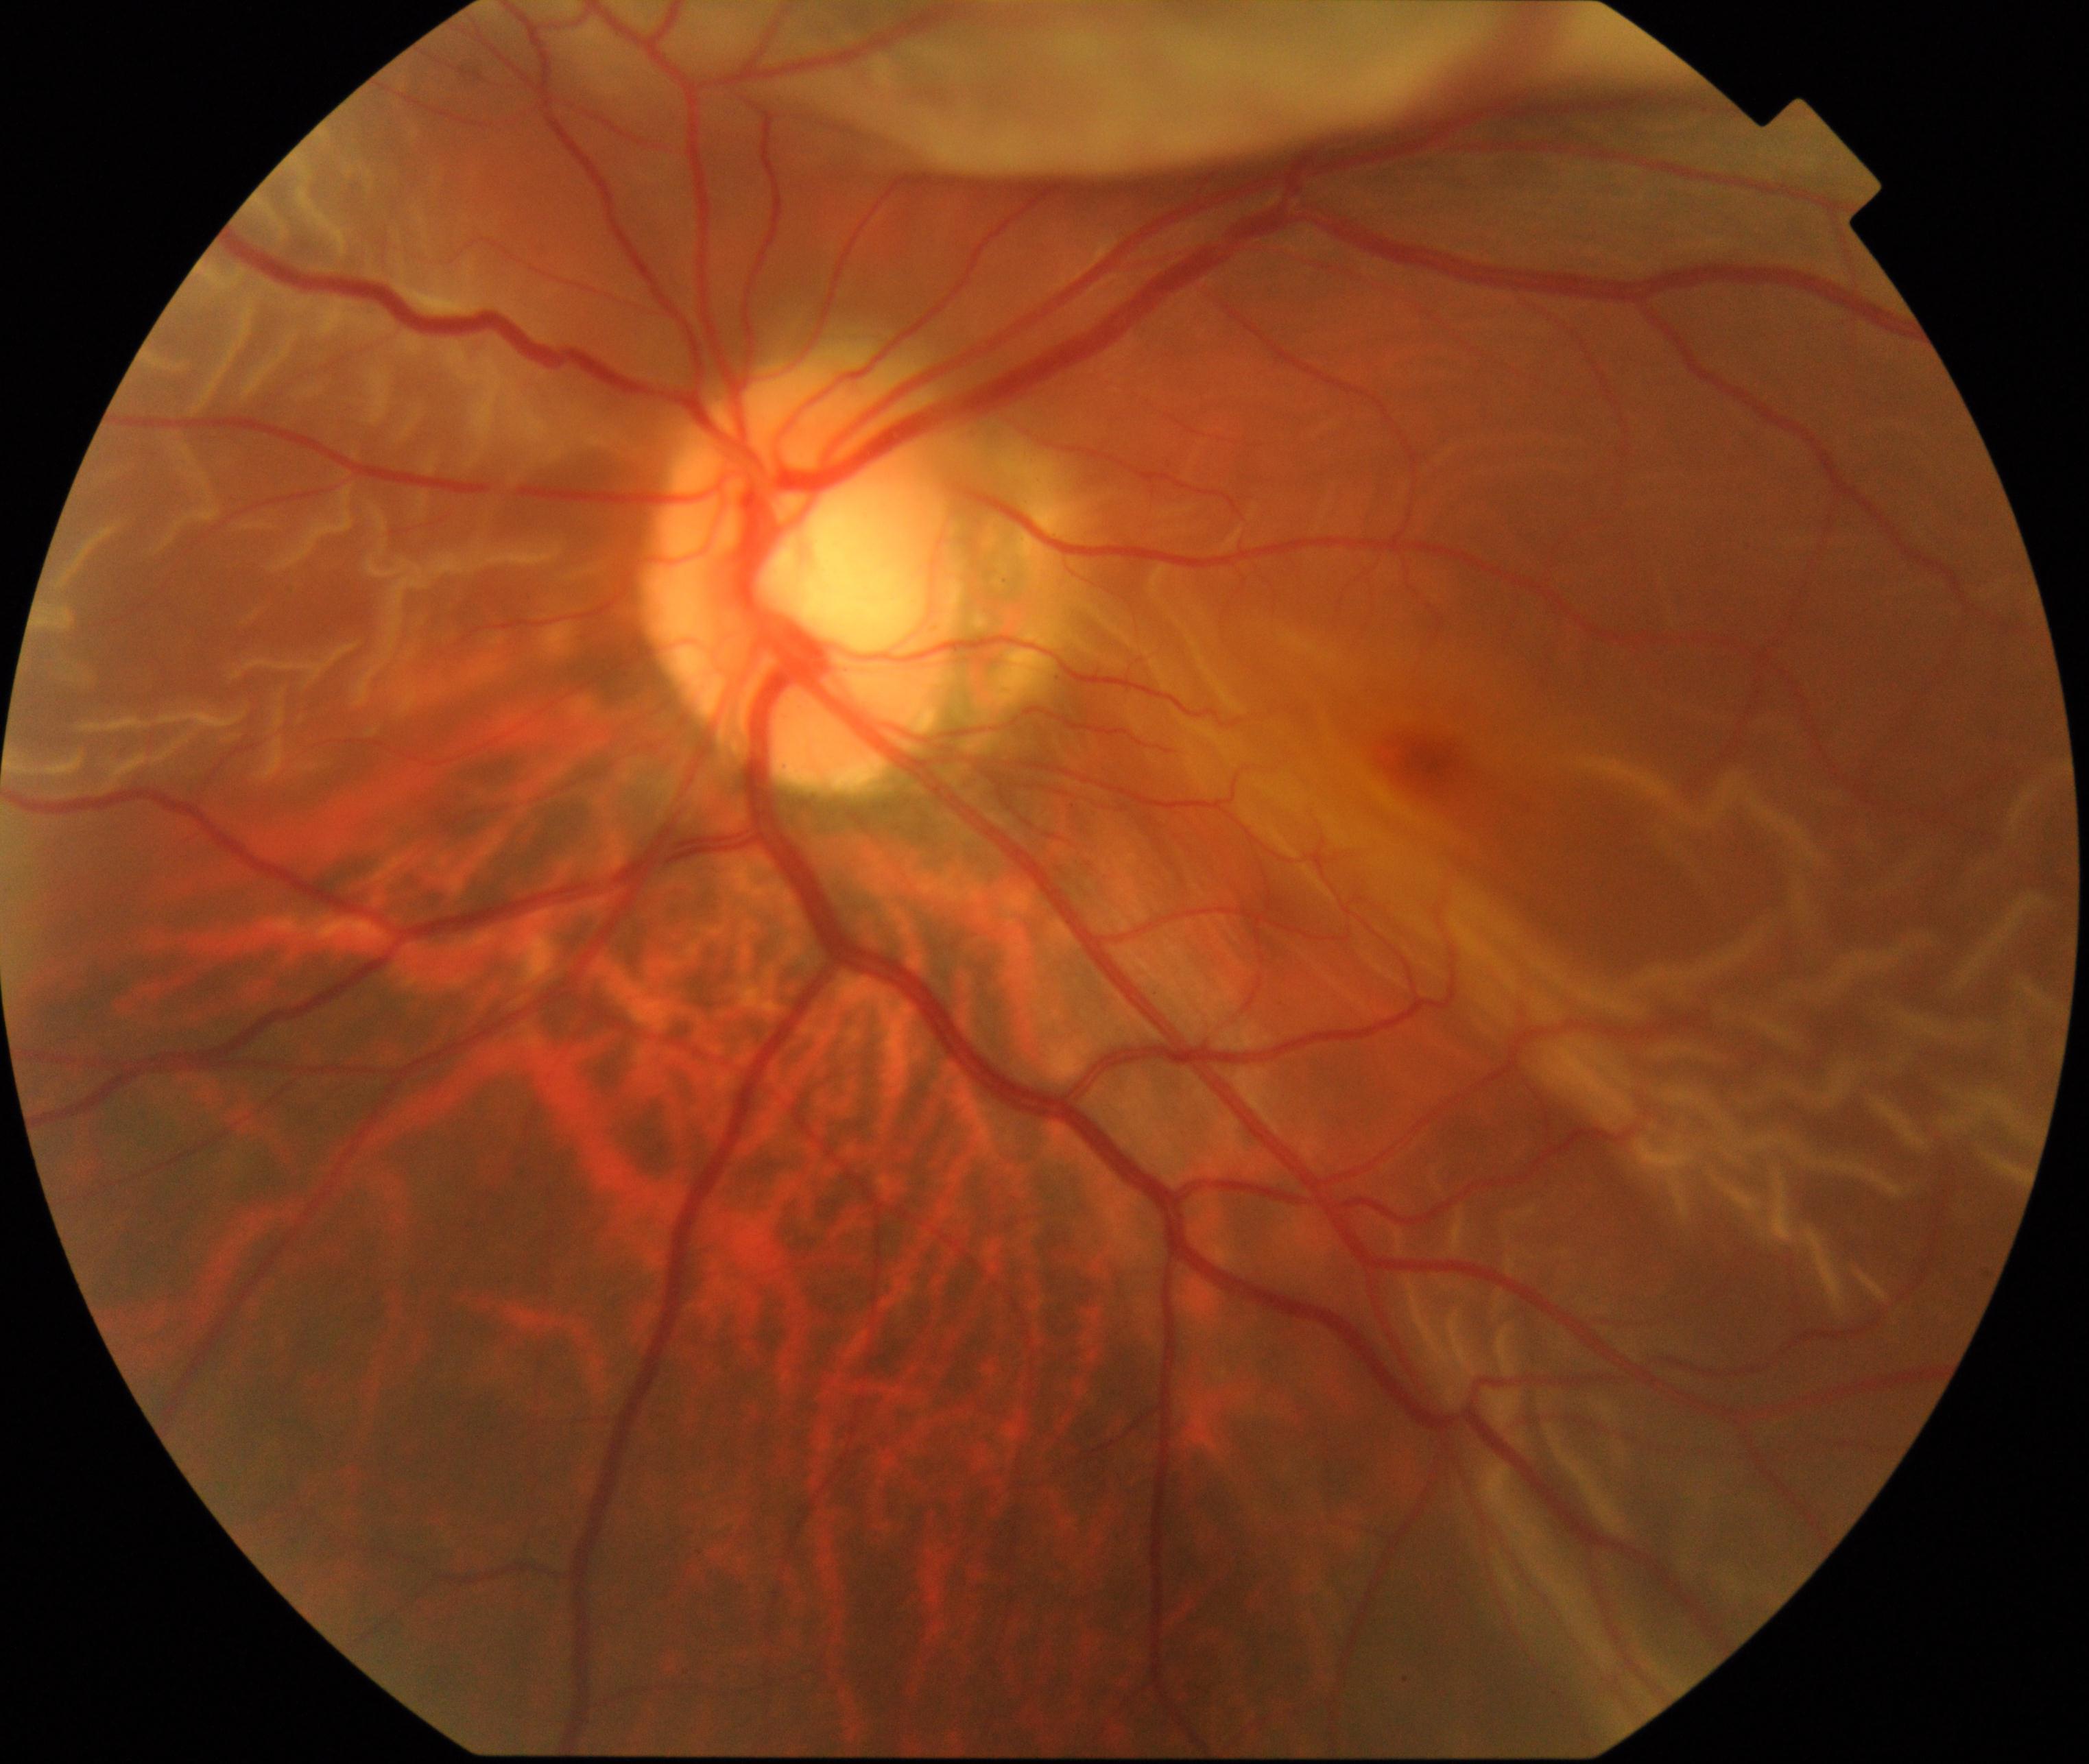 Primary finding: rhegmatogenous retinal detachment.